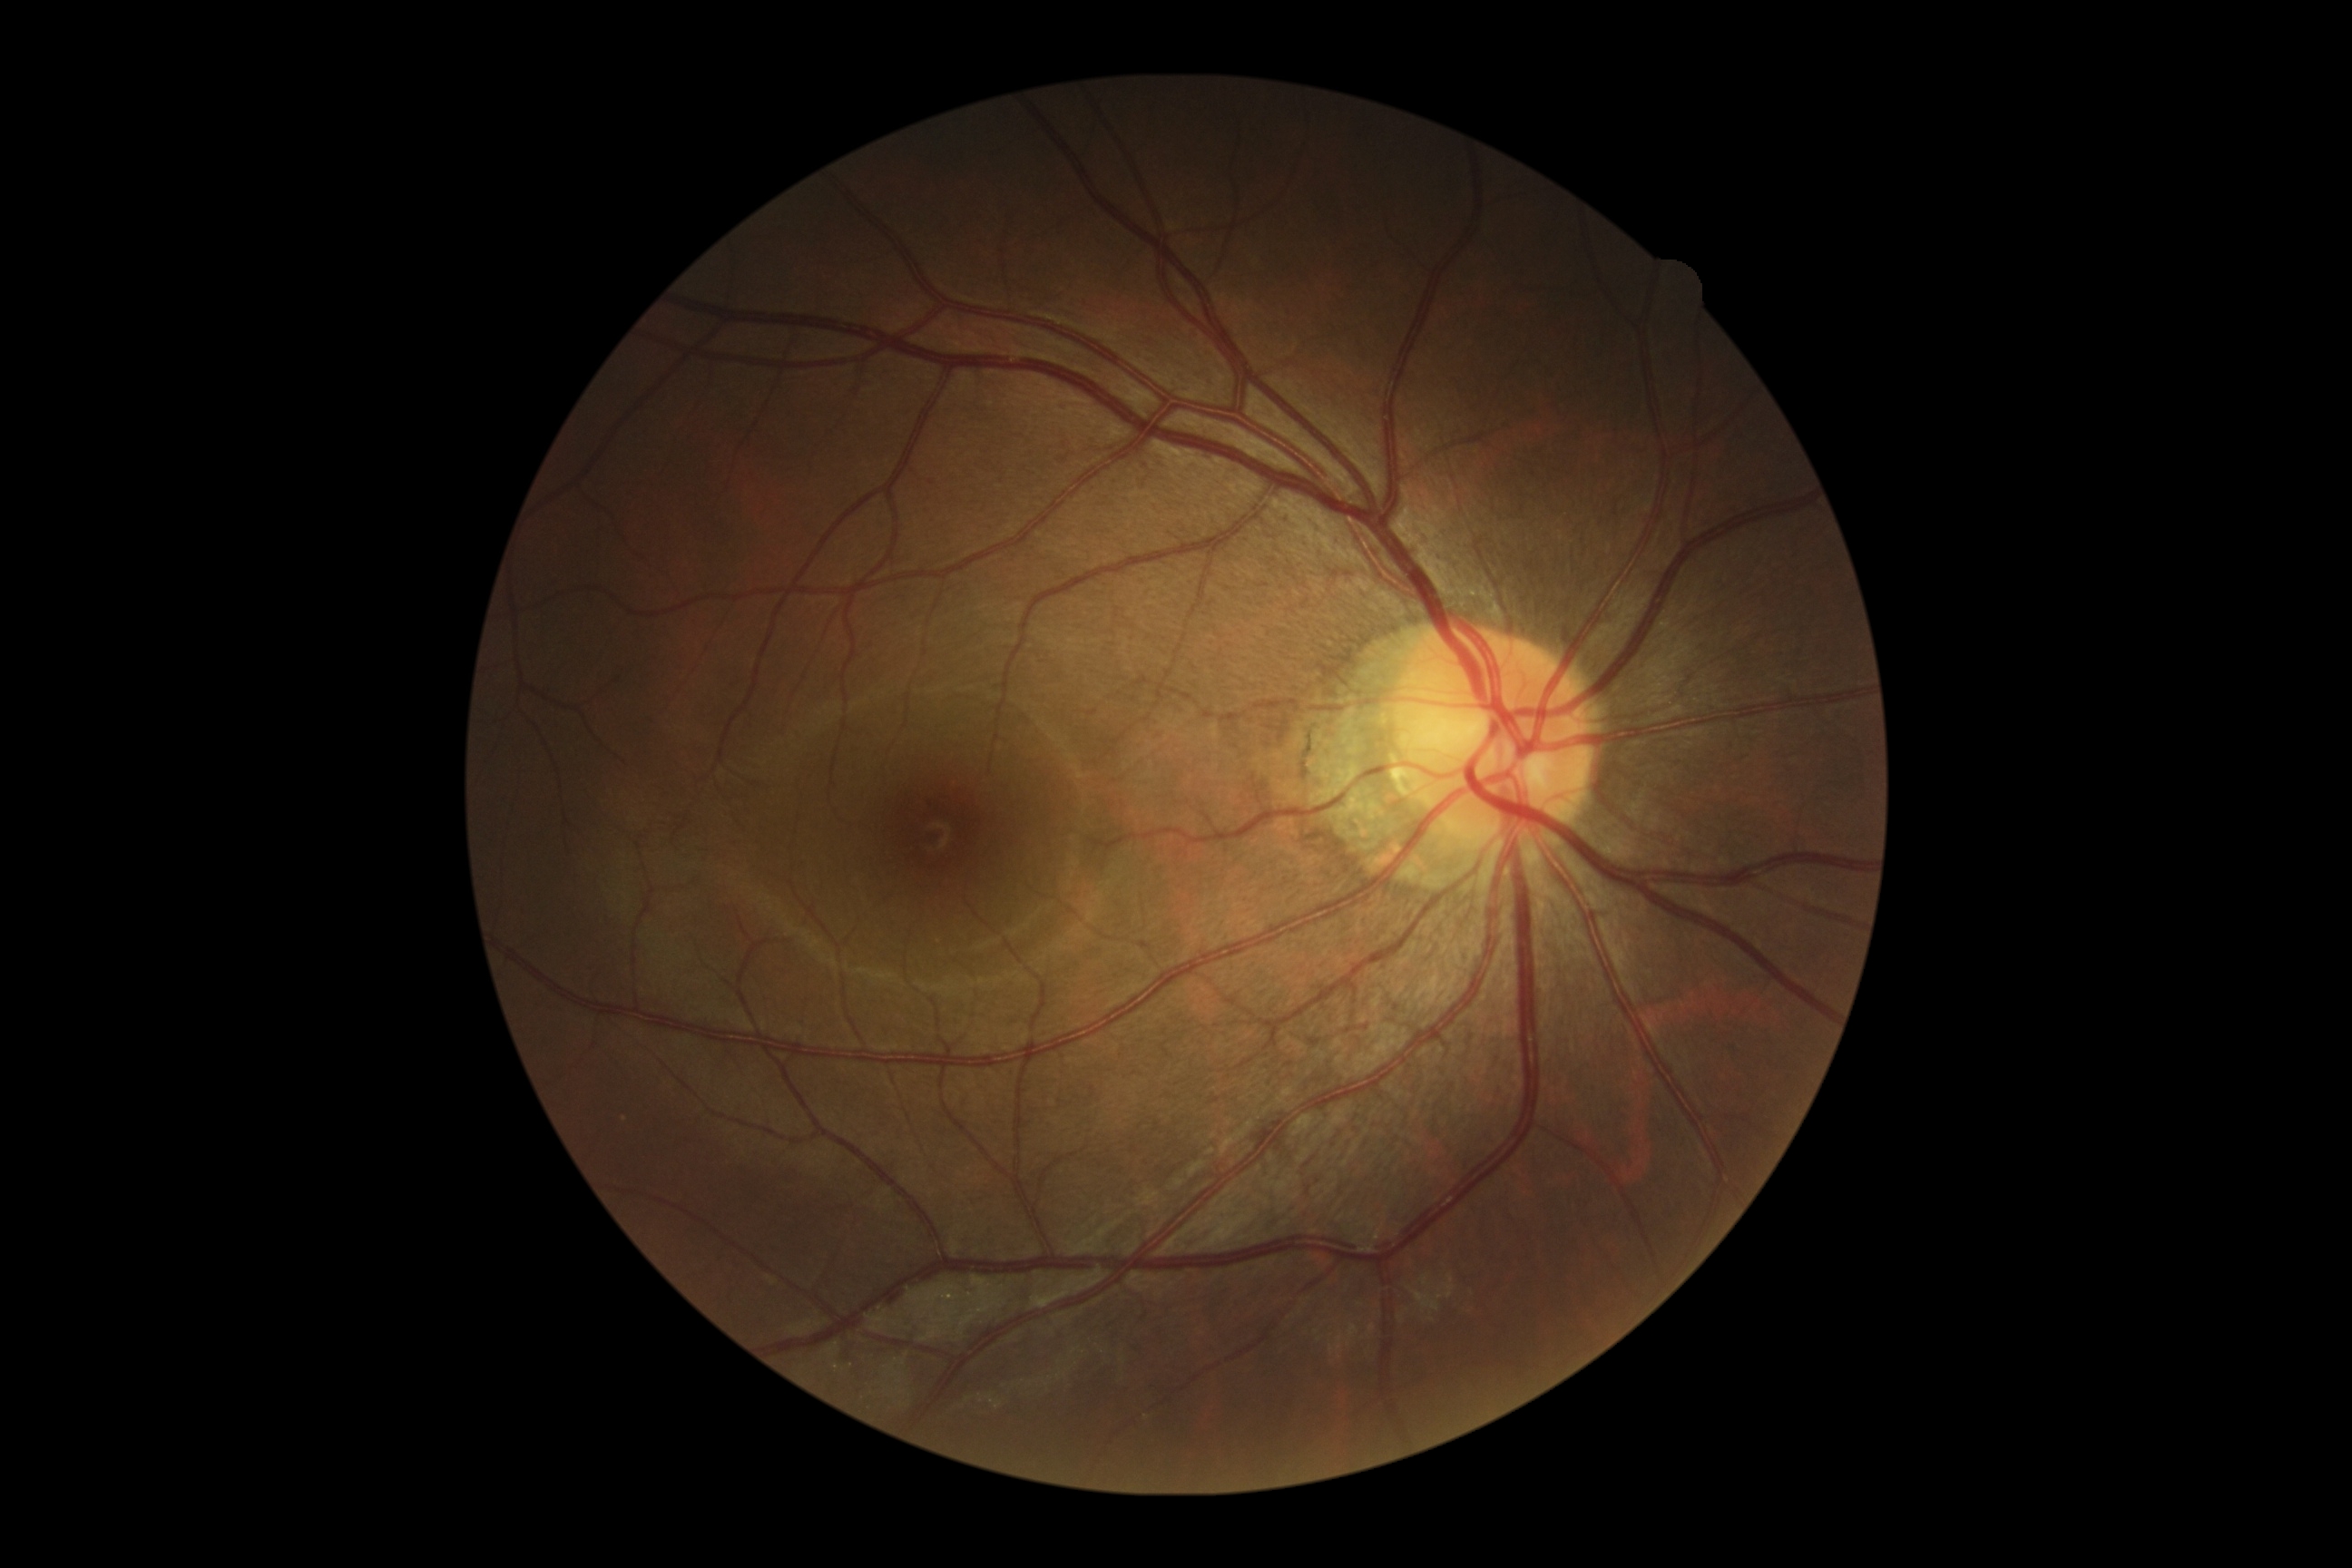   dr_grade: 0 (no apparent retinopathy)